45° field of view. Without pupil dilation: 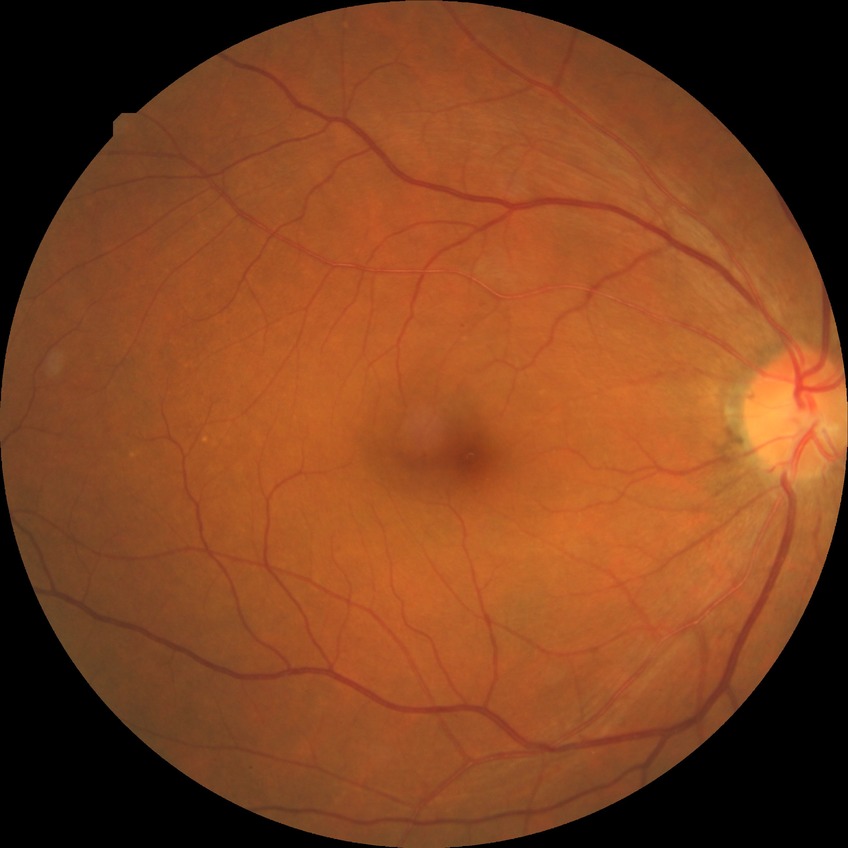

– diabetic retinopathy (DR) — simple diabetic retinopathy (SDR)